Posterior pole photograph — 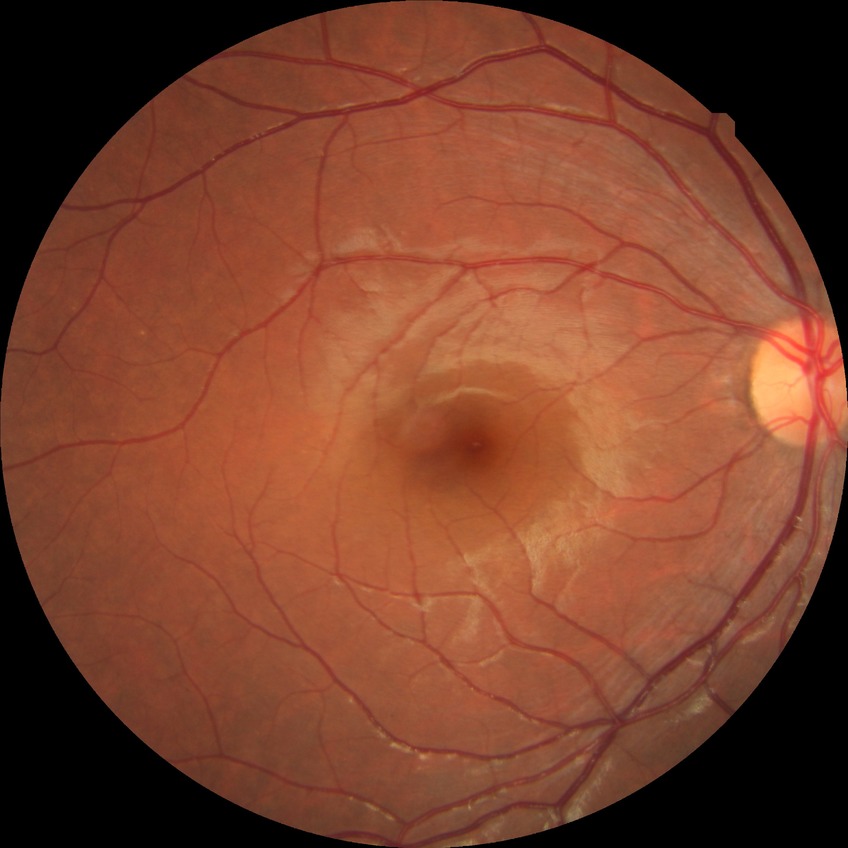
Modified Davis grading is no diabetic retinopathy.